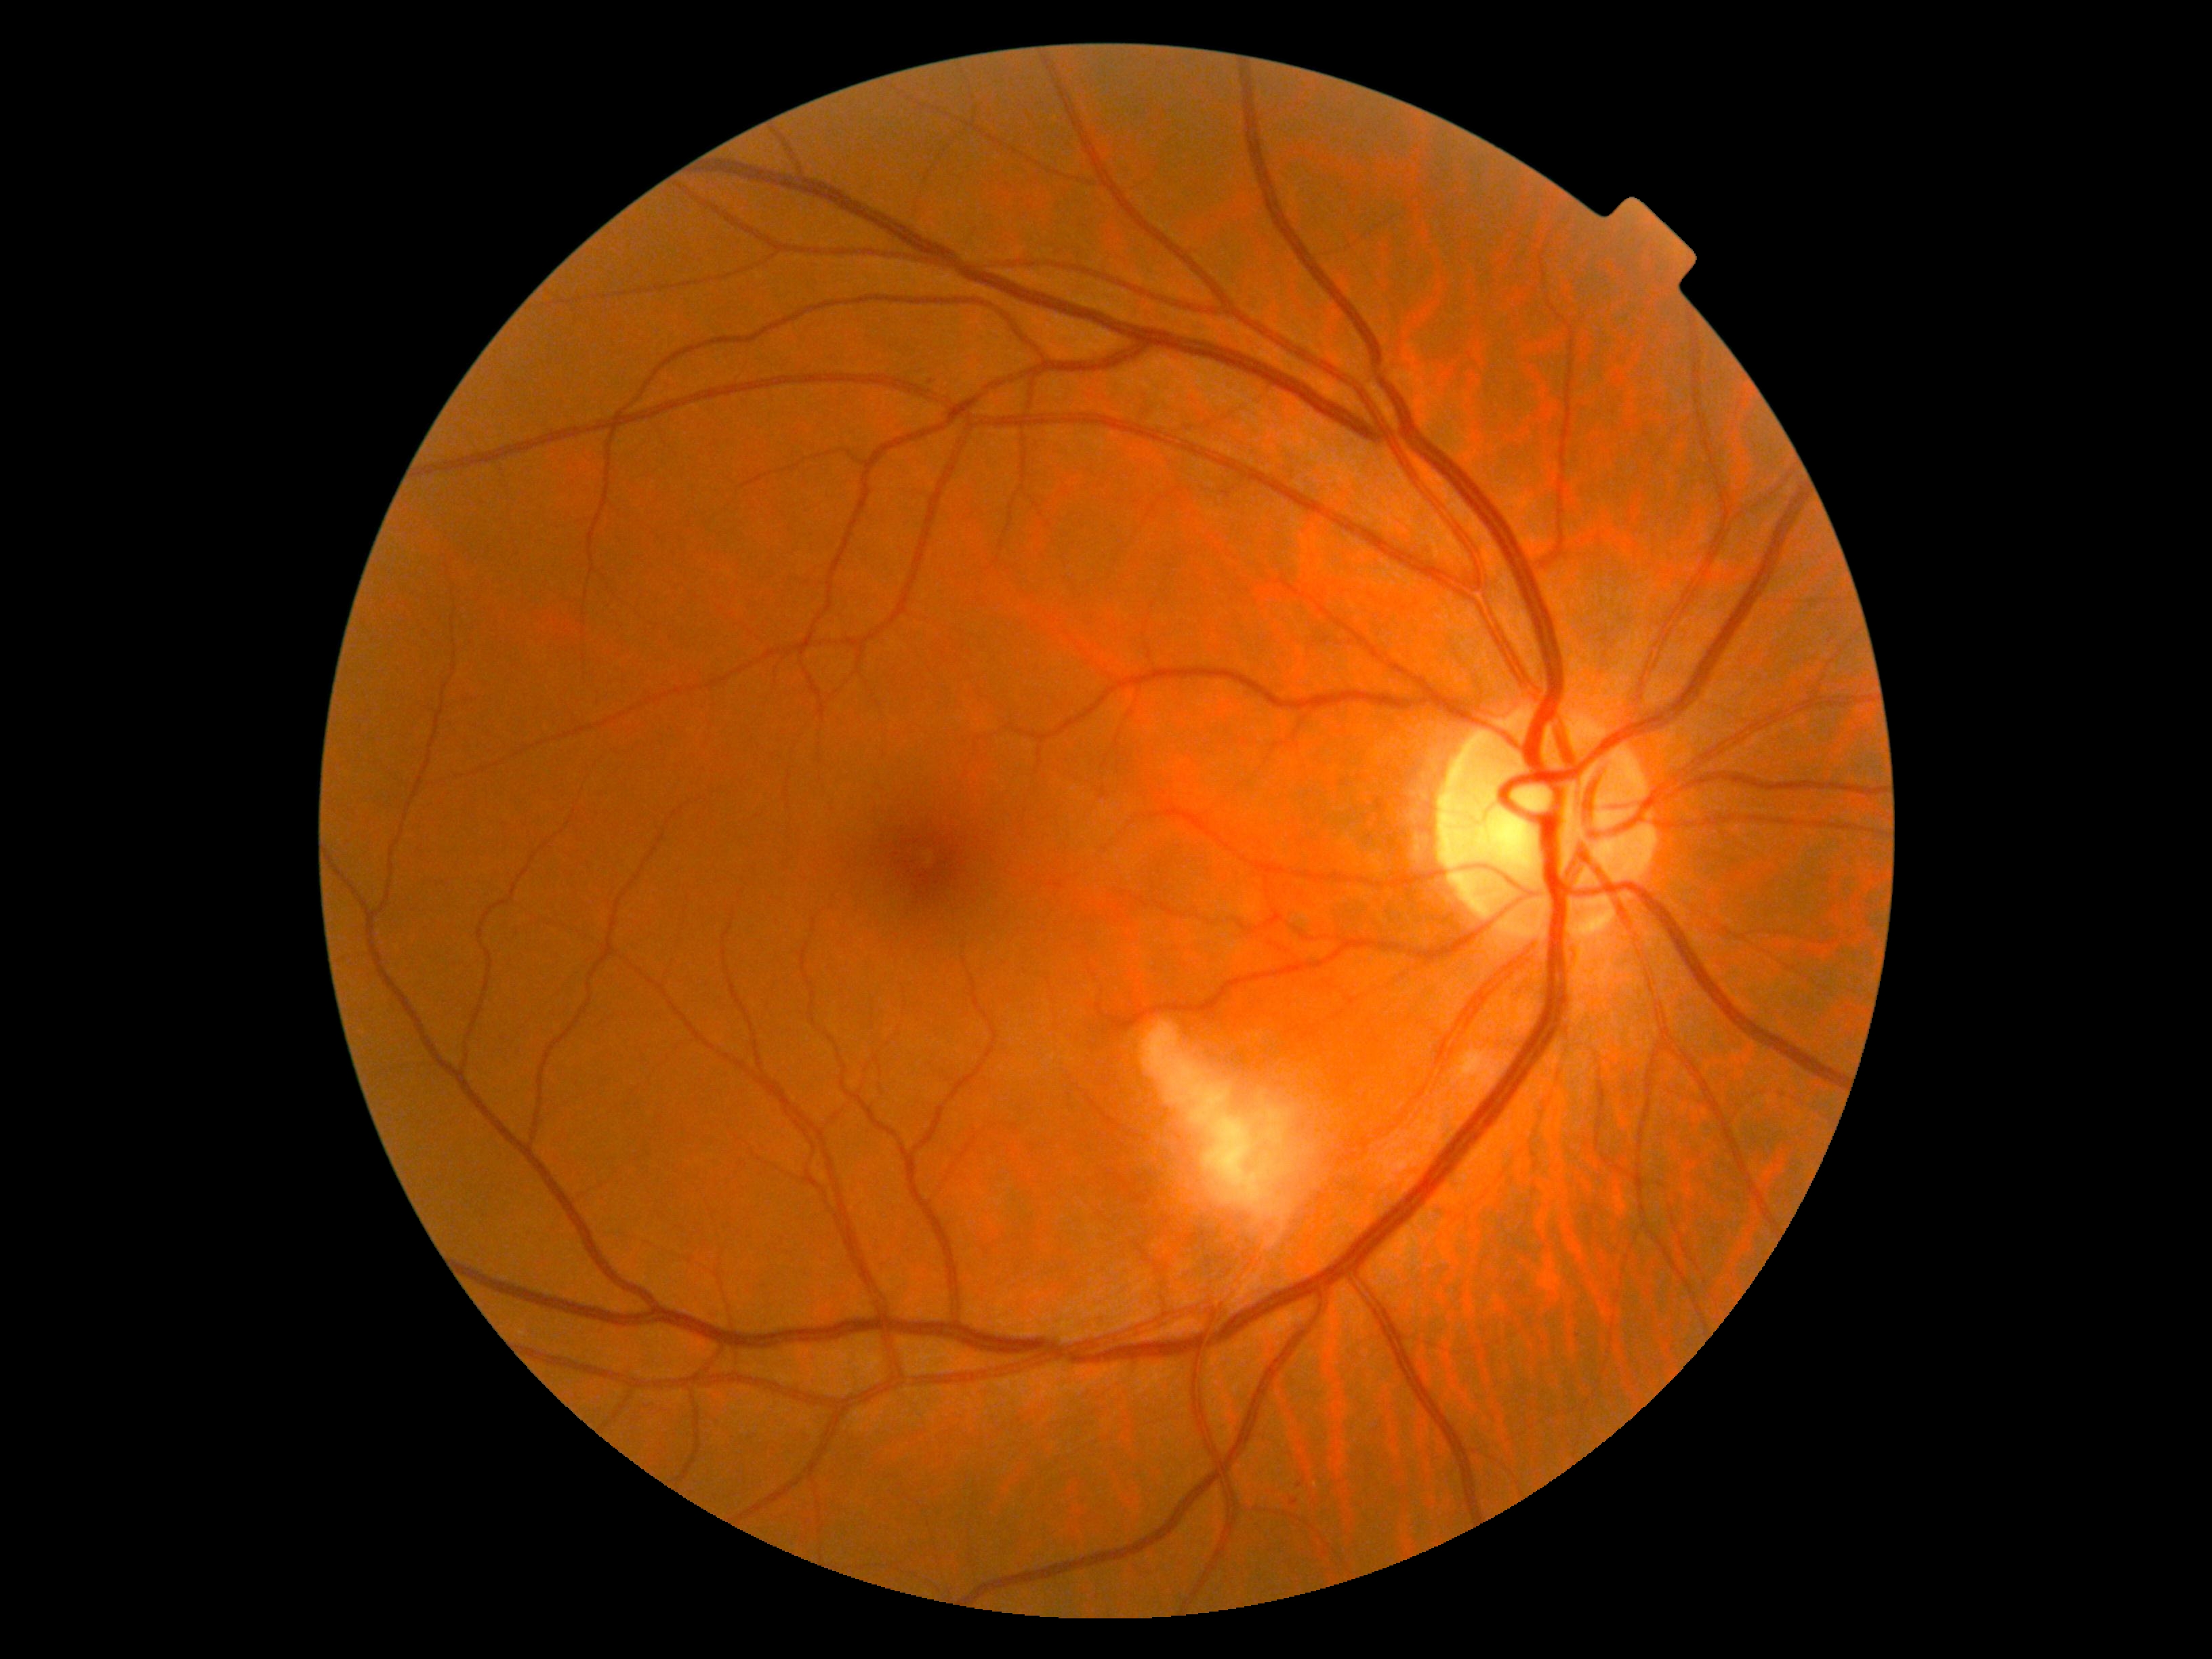
DR class = non-proliferative diabetic retinopathy; retinopathy grade = 2 (moderate NPDR).